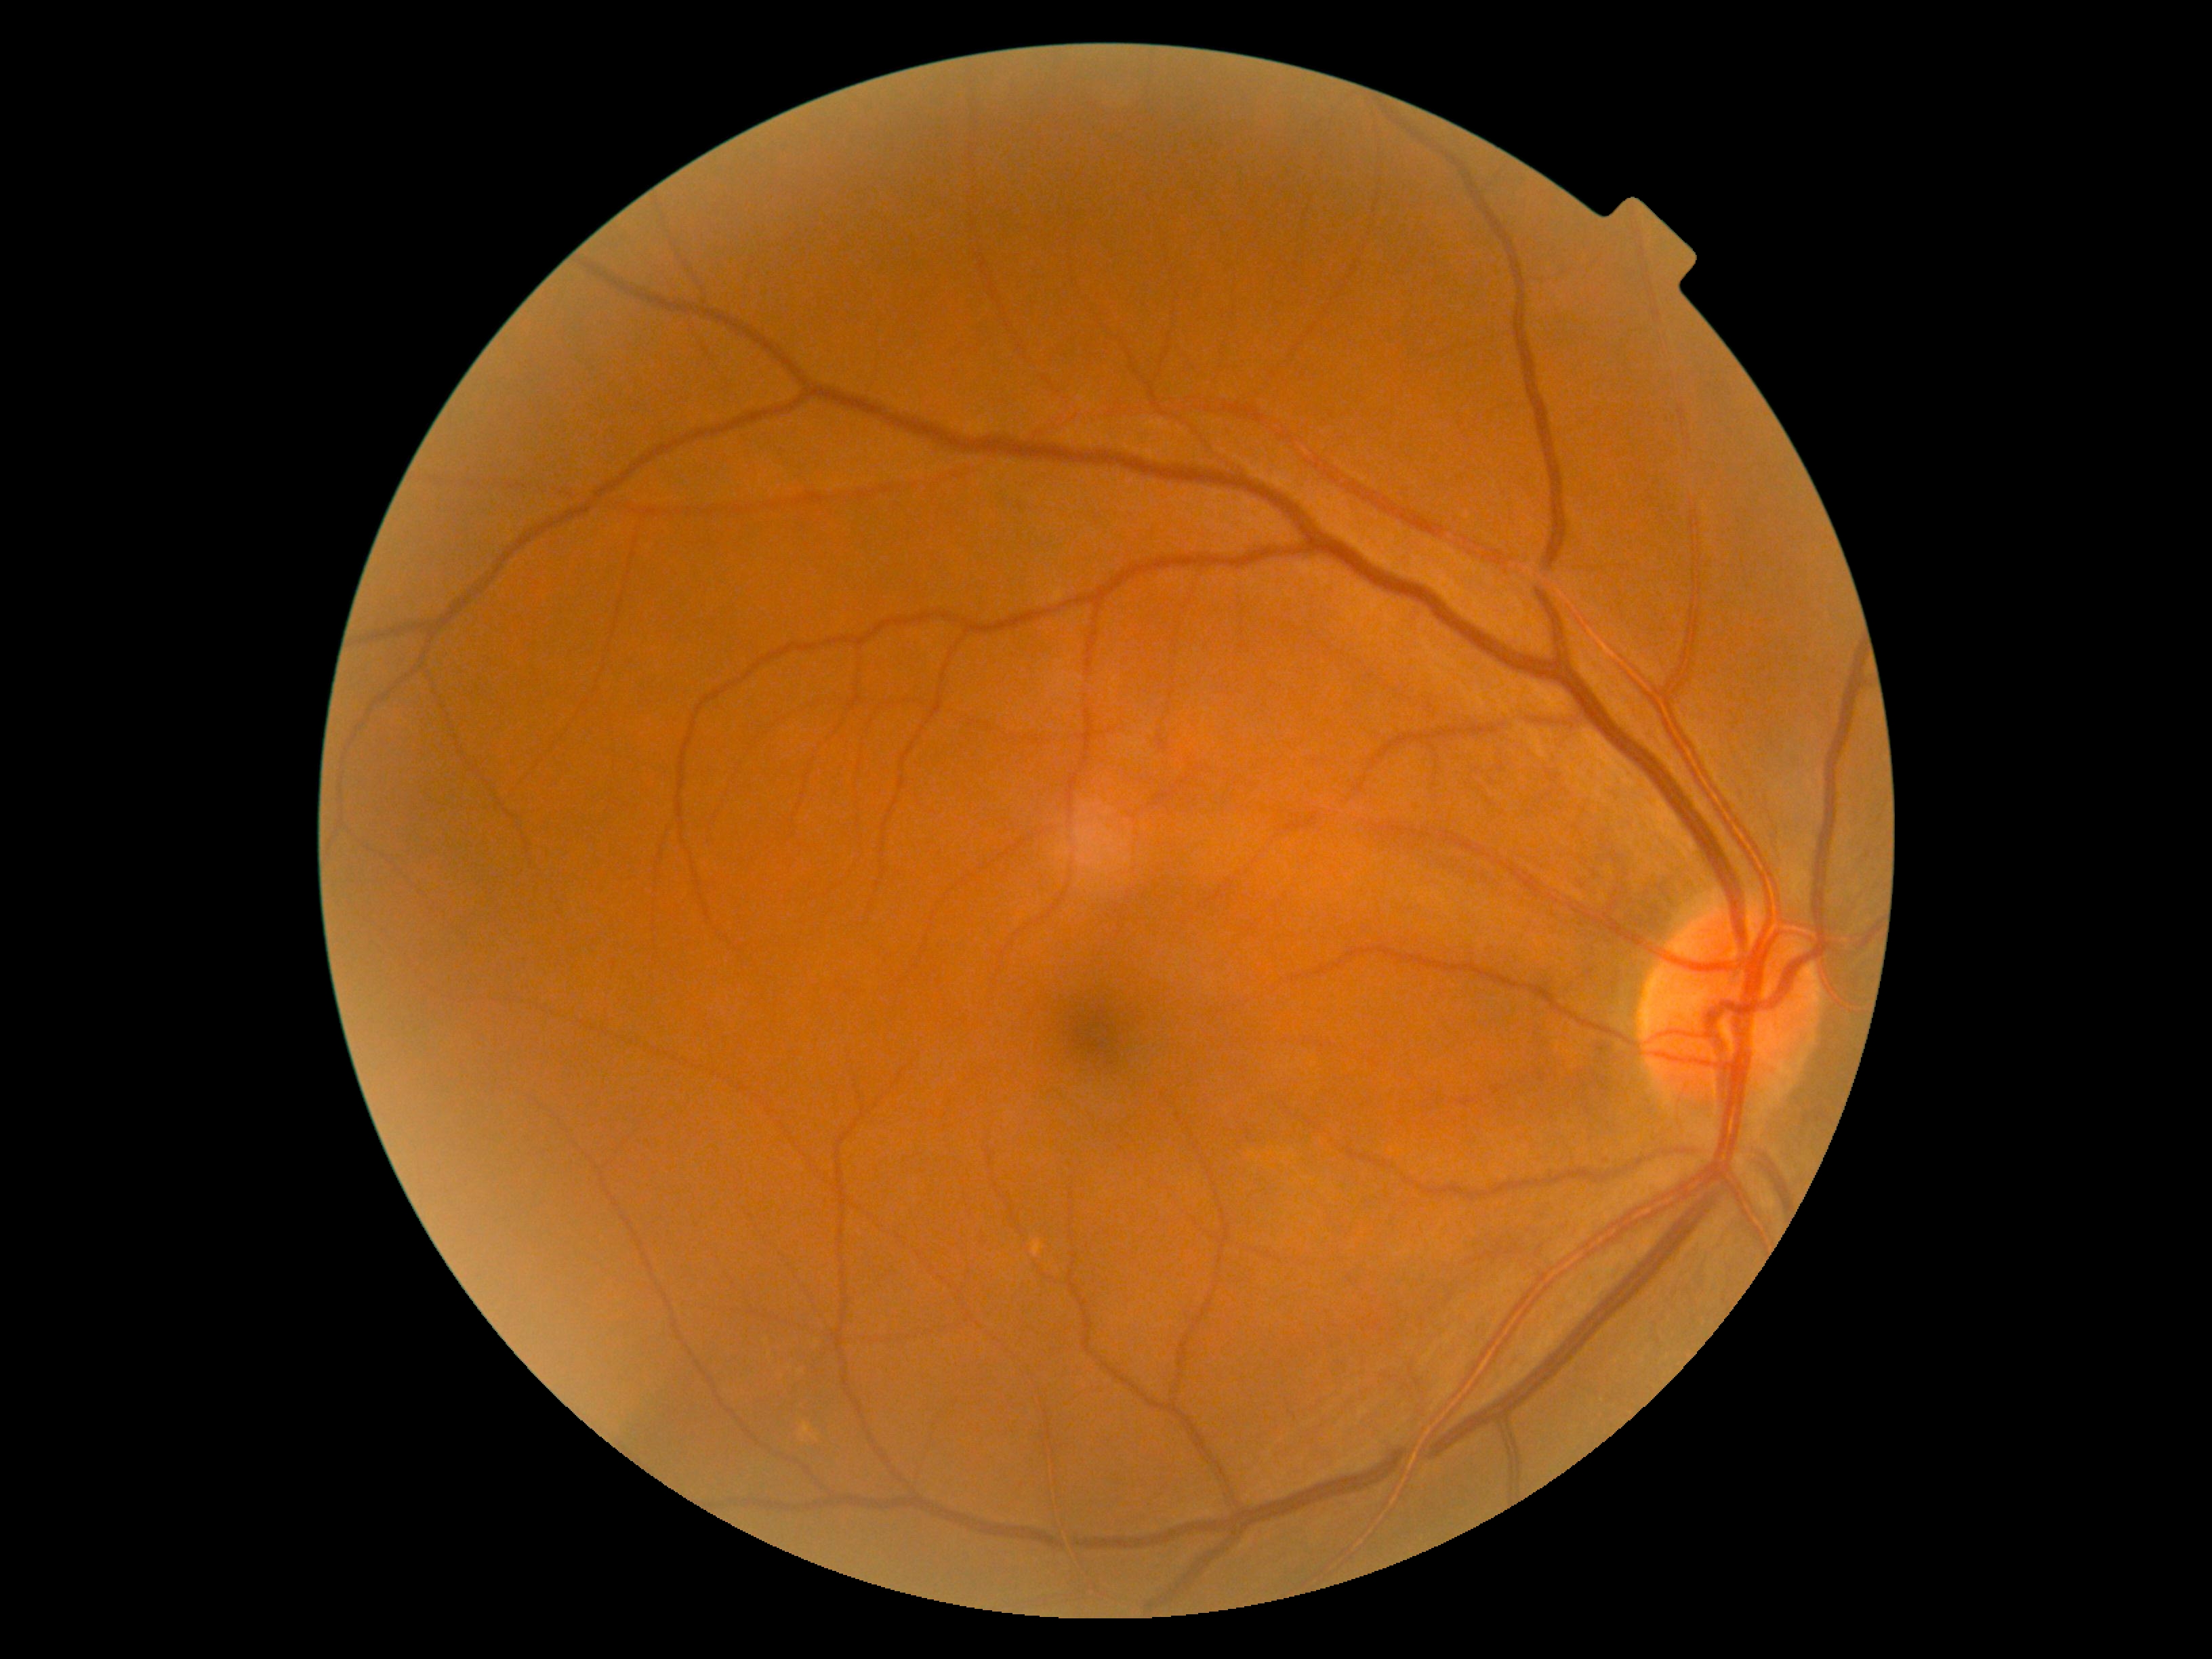
No diabetic retinal disease findings.
DR grade is 0 (no apparent retinopathy).